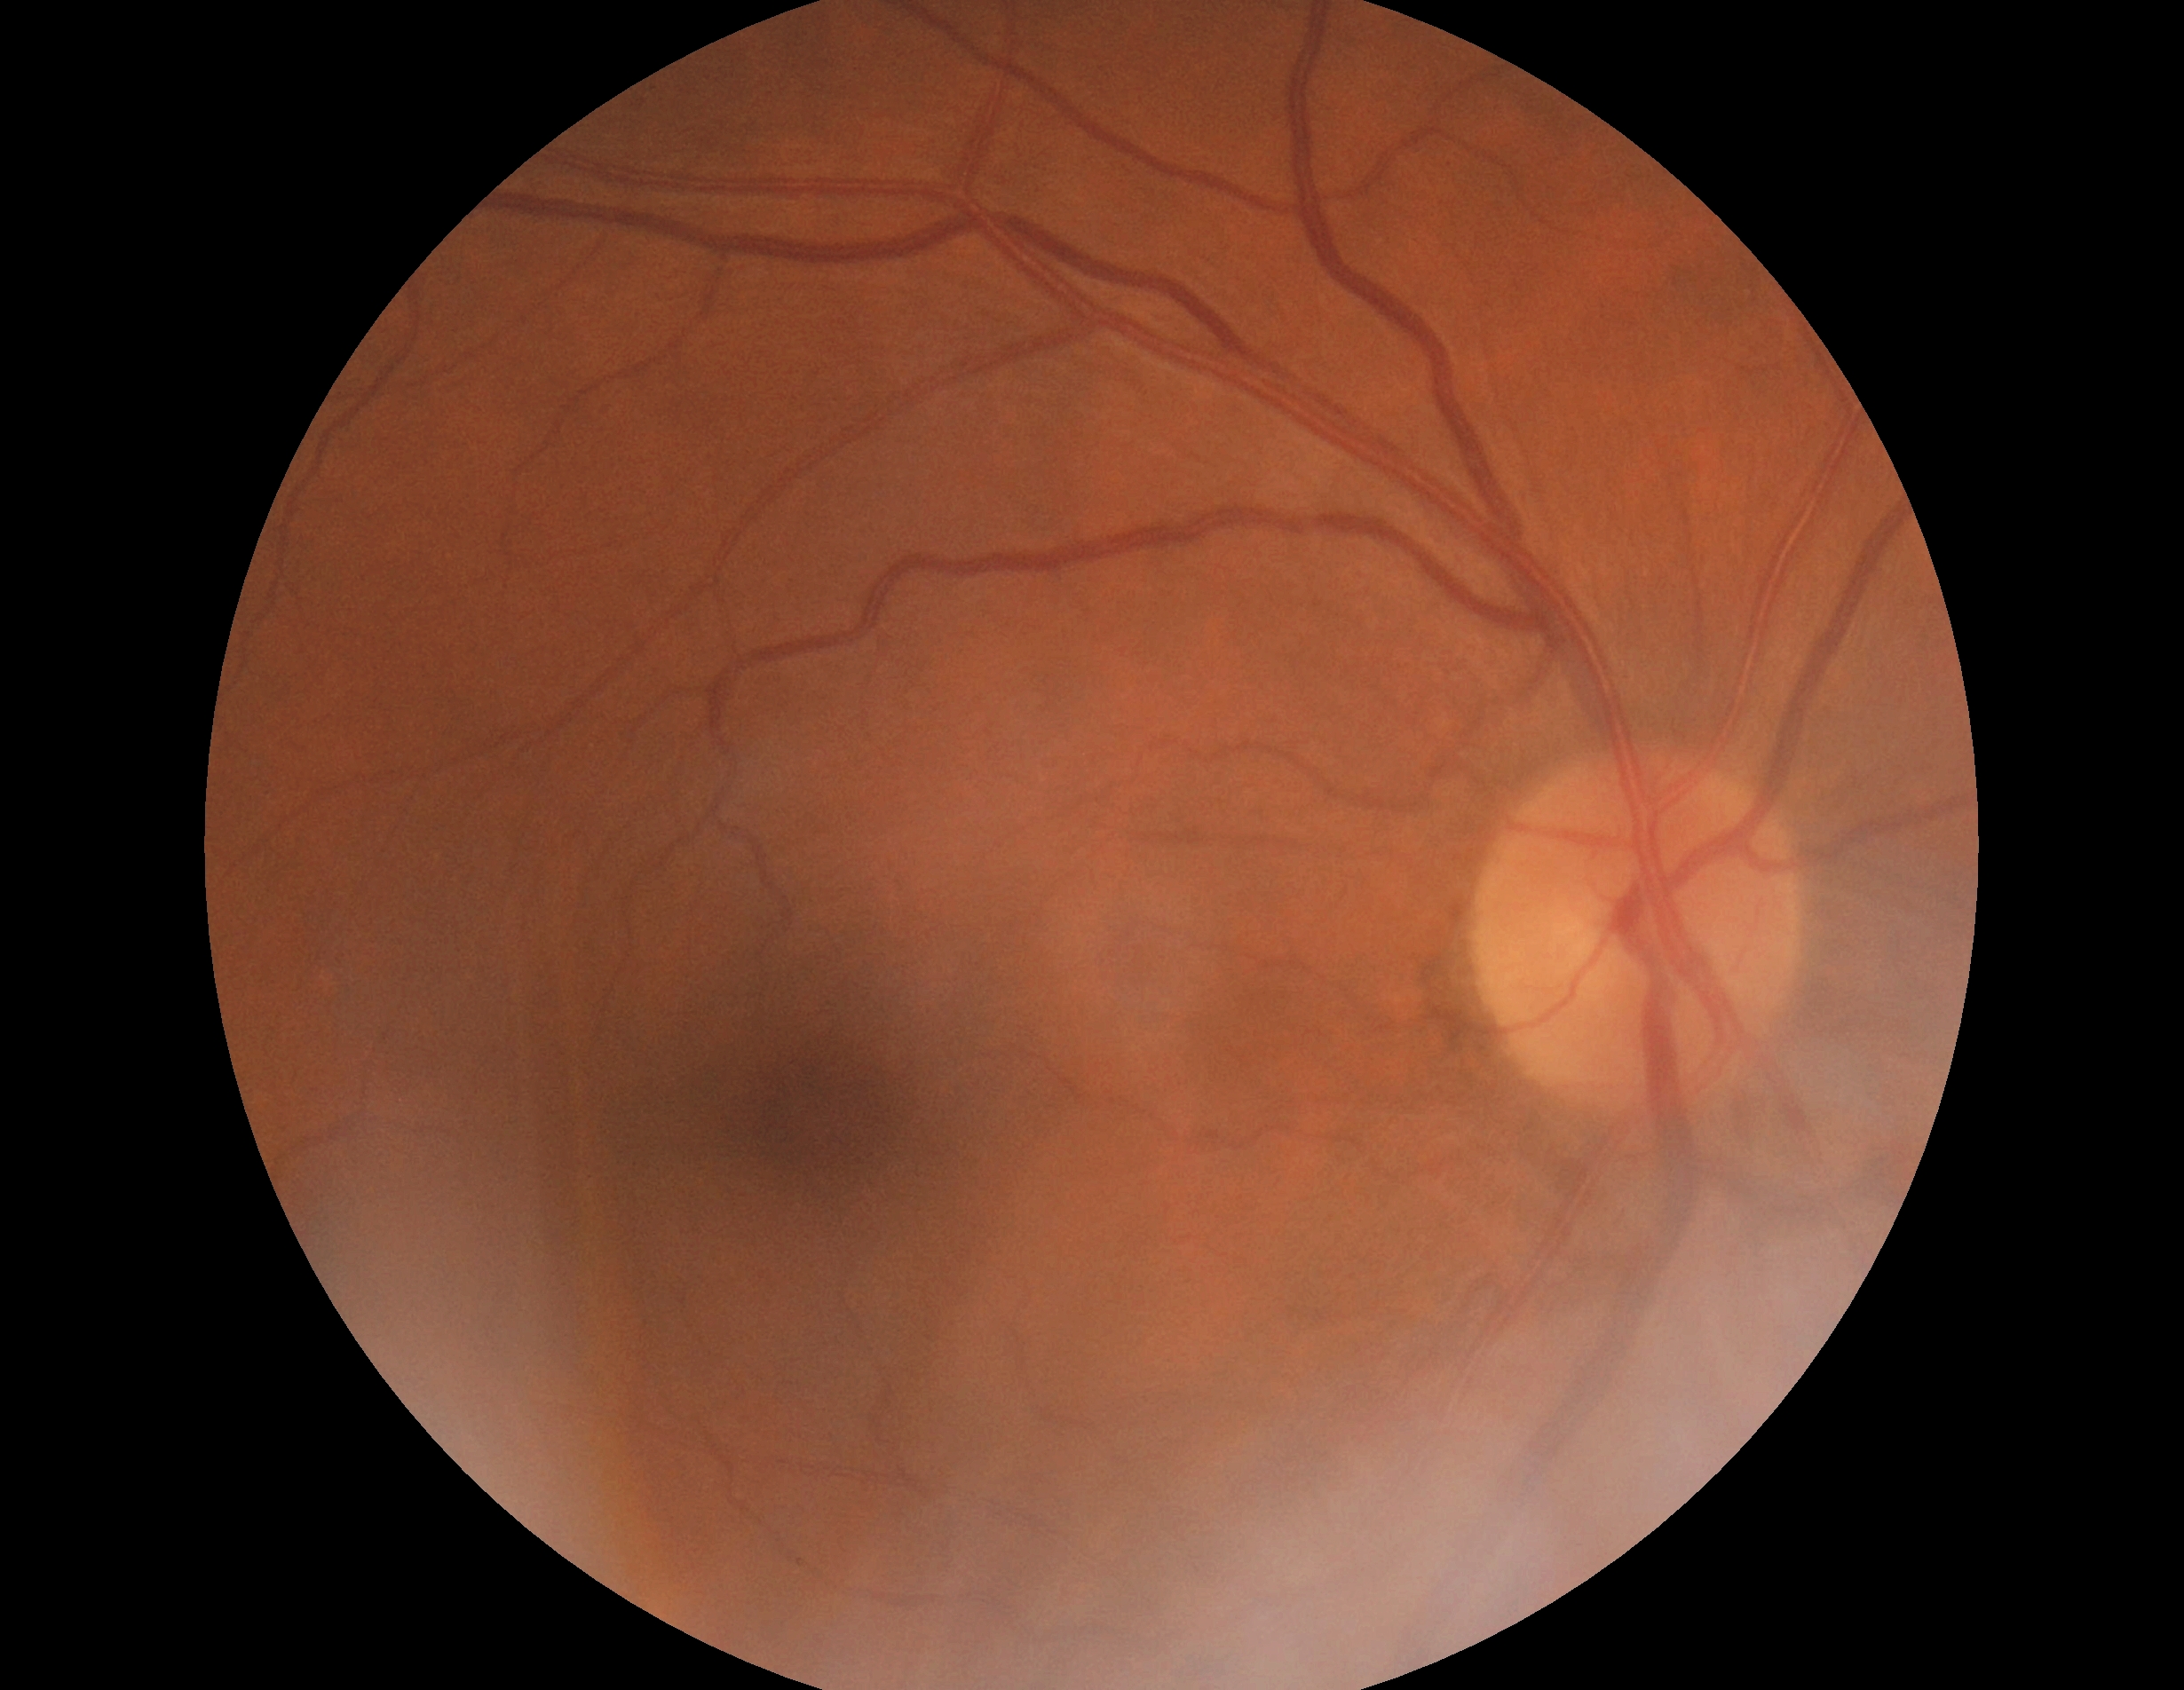

DR grade: 0 (no apparent retinopathy).